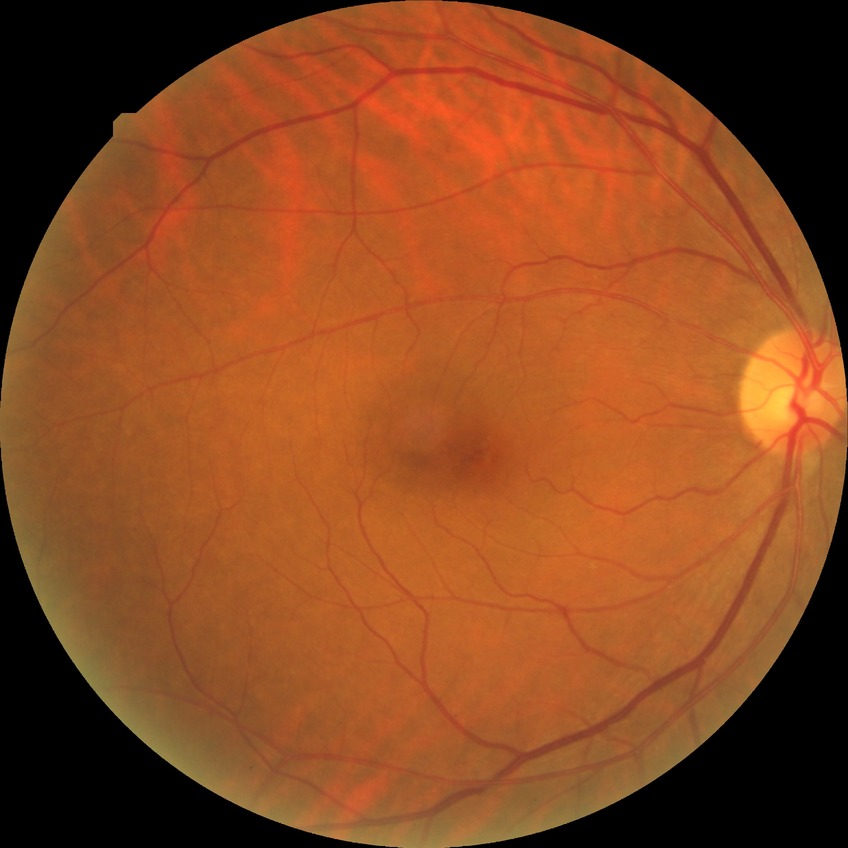
{
  "davis_grade": "NDR",
  "dr_impression": "no signs of DR"
}